FOV: 50 degrees · captured on a Topcon TRC-50DX fundus camera · color fundus image
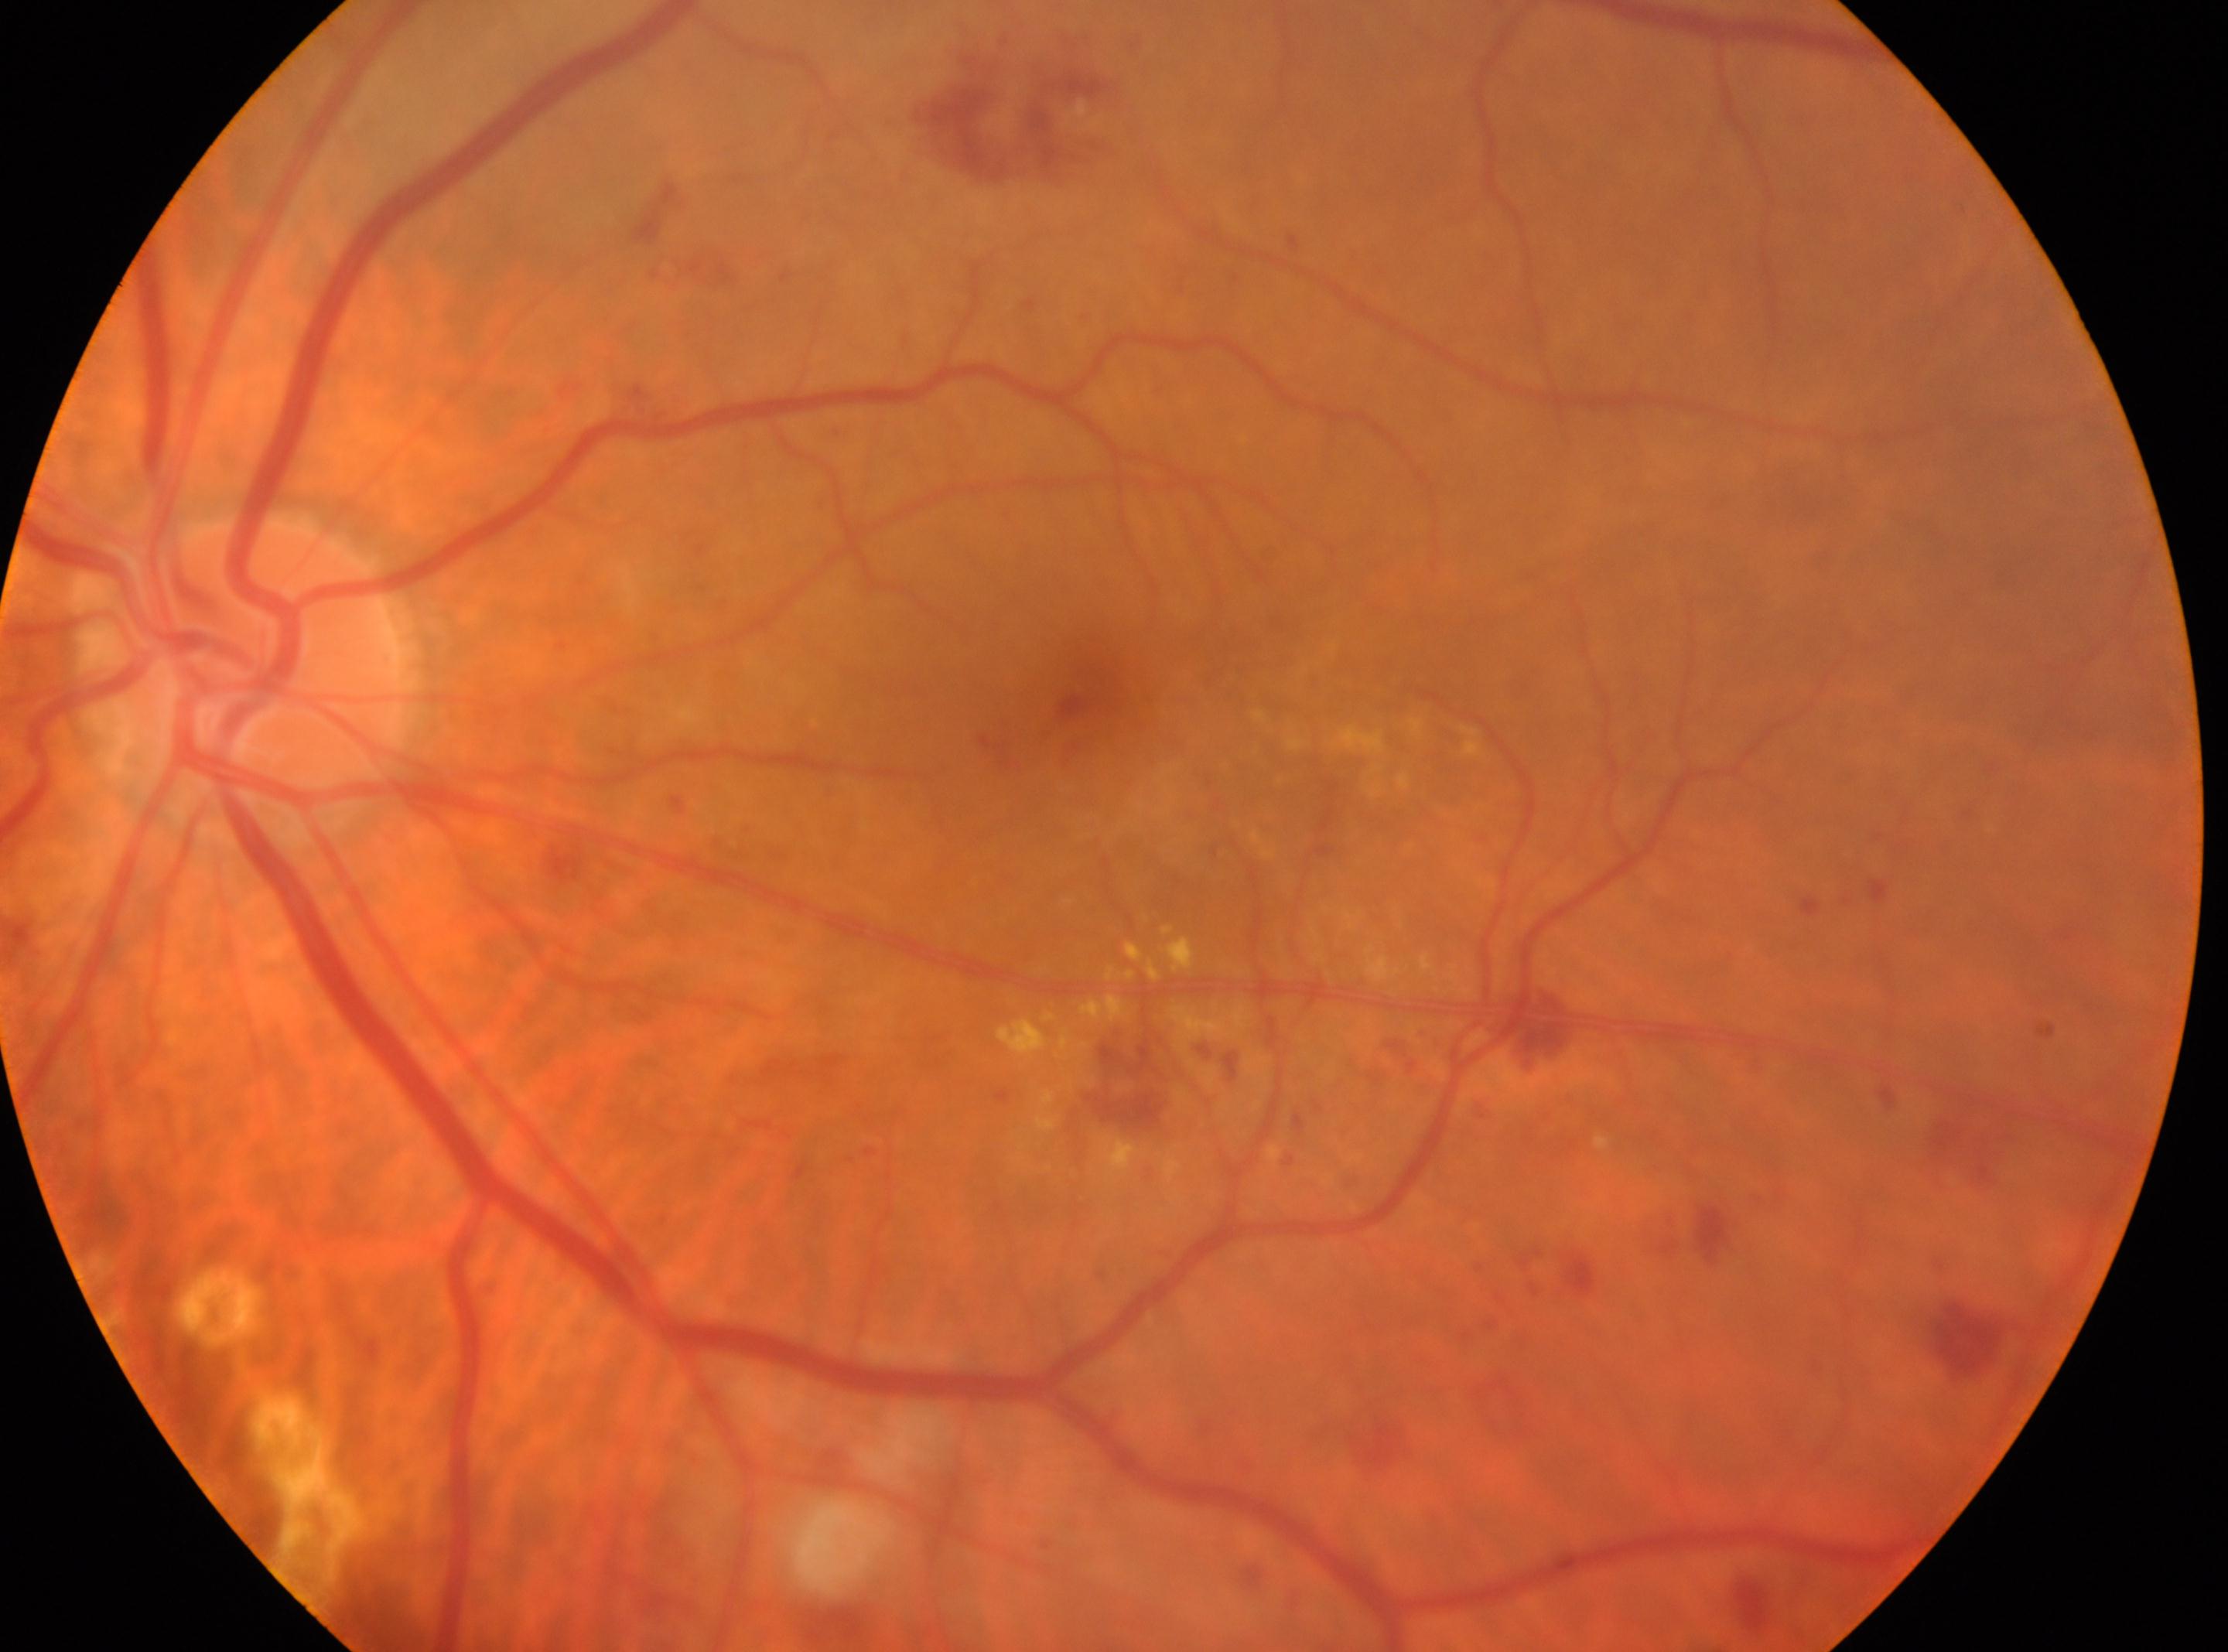
  dr_grade: moderate non-proliferative diabetic retinopathy (grade 2)
  fovea: 1088px, 699px
  eye: left
  optic_disc: 257px, 664px